848 x 848 pixels · posterior pole color fundus photograph · 45-degree field of view · NIDEK AFC-230 fundus camera.
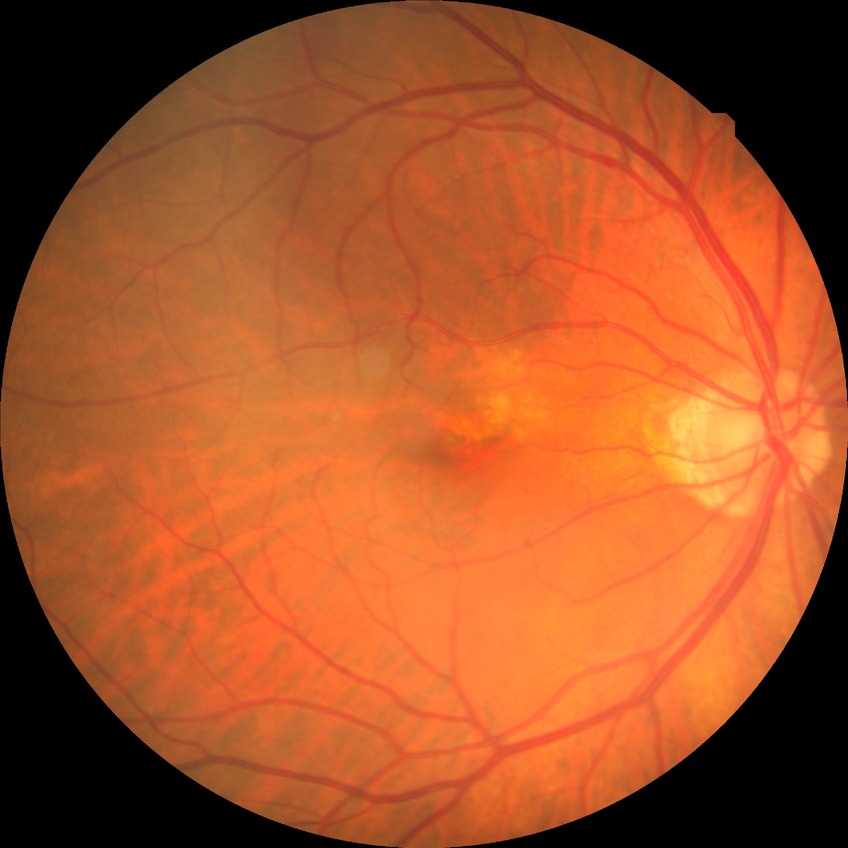
Diabetic retinopathy (DR): no diabetic retinopathy (NDR).